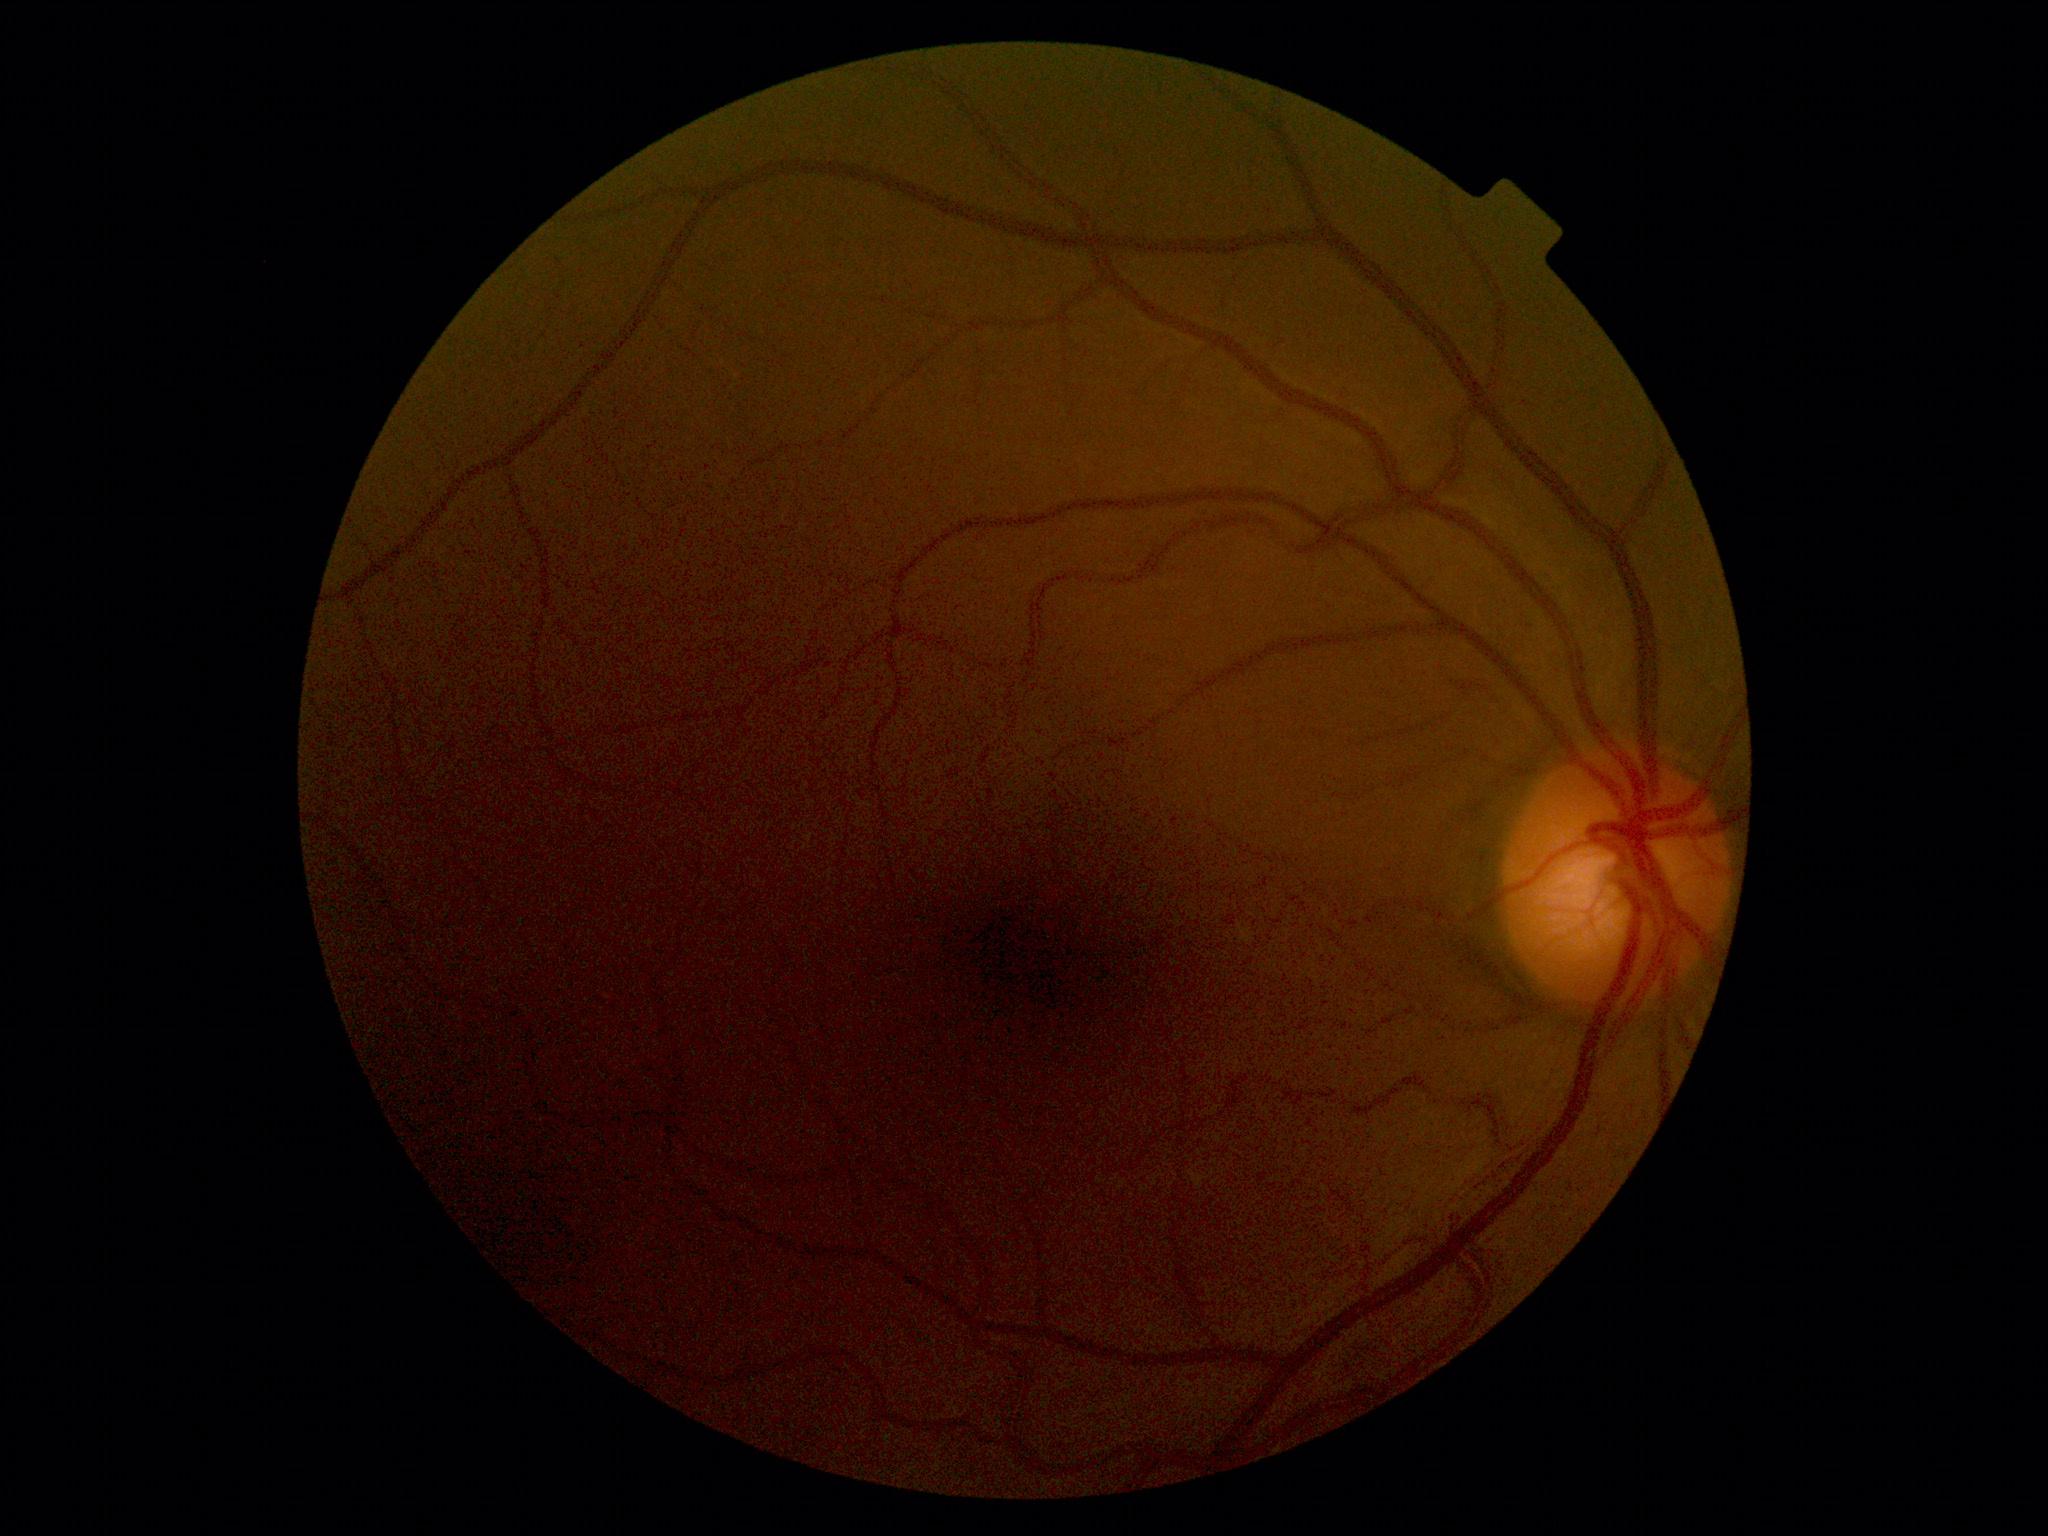
No signs of diabetic retinopathy.
DR stage is grade 0 (no apparent retinopathy).